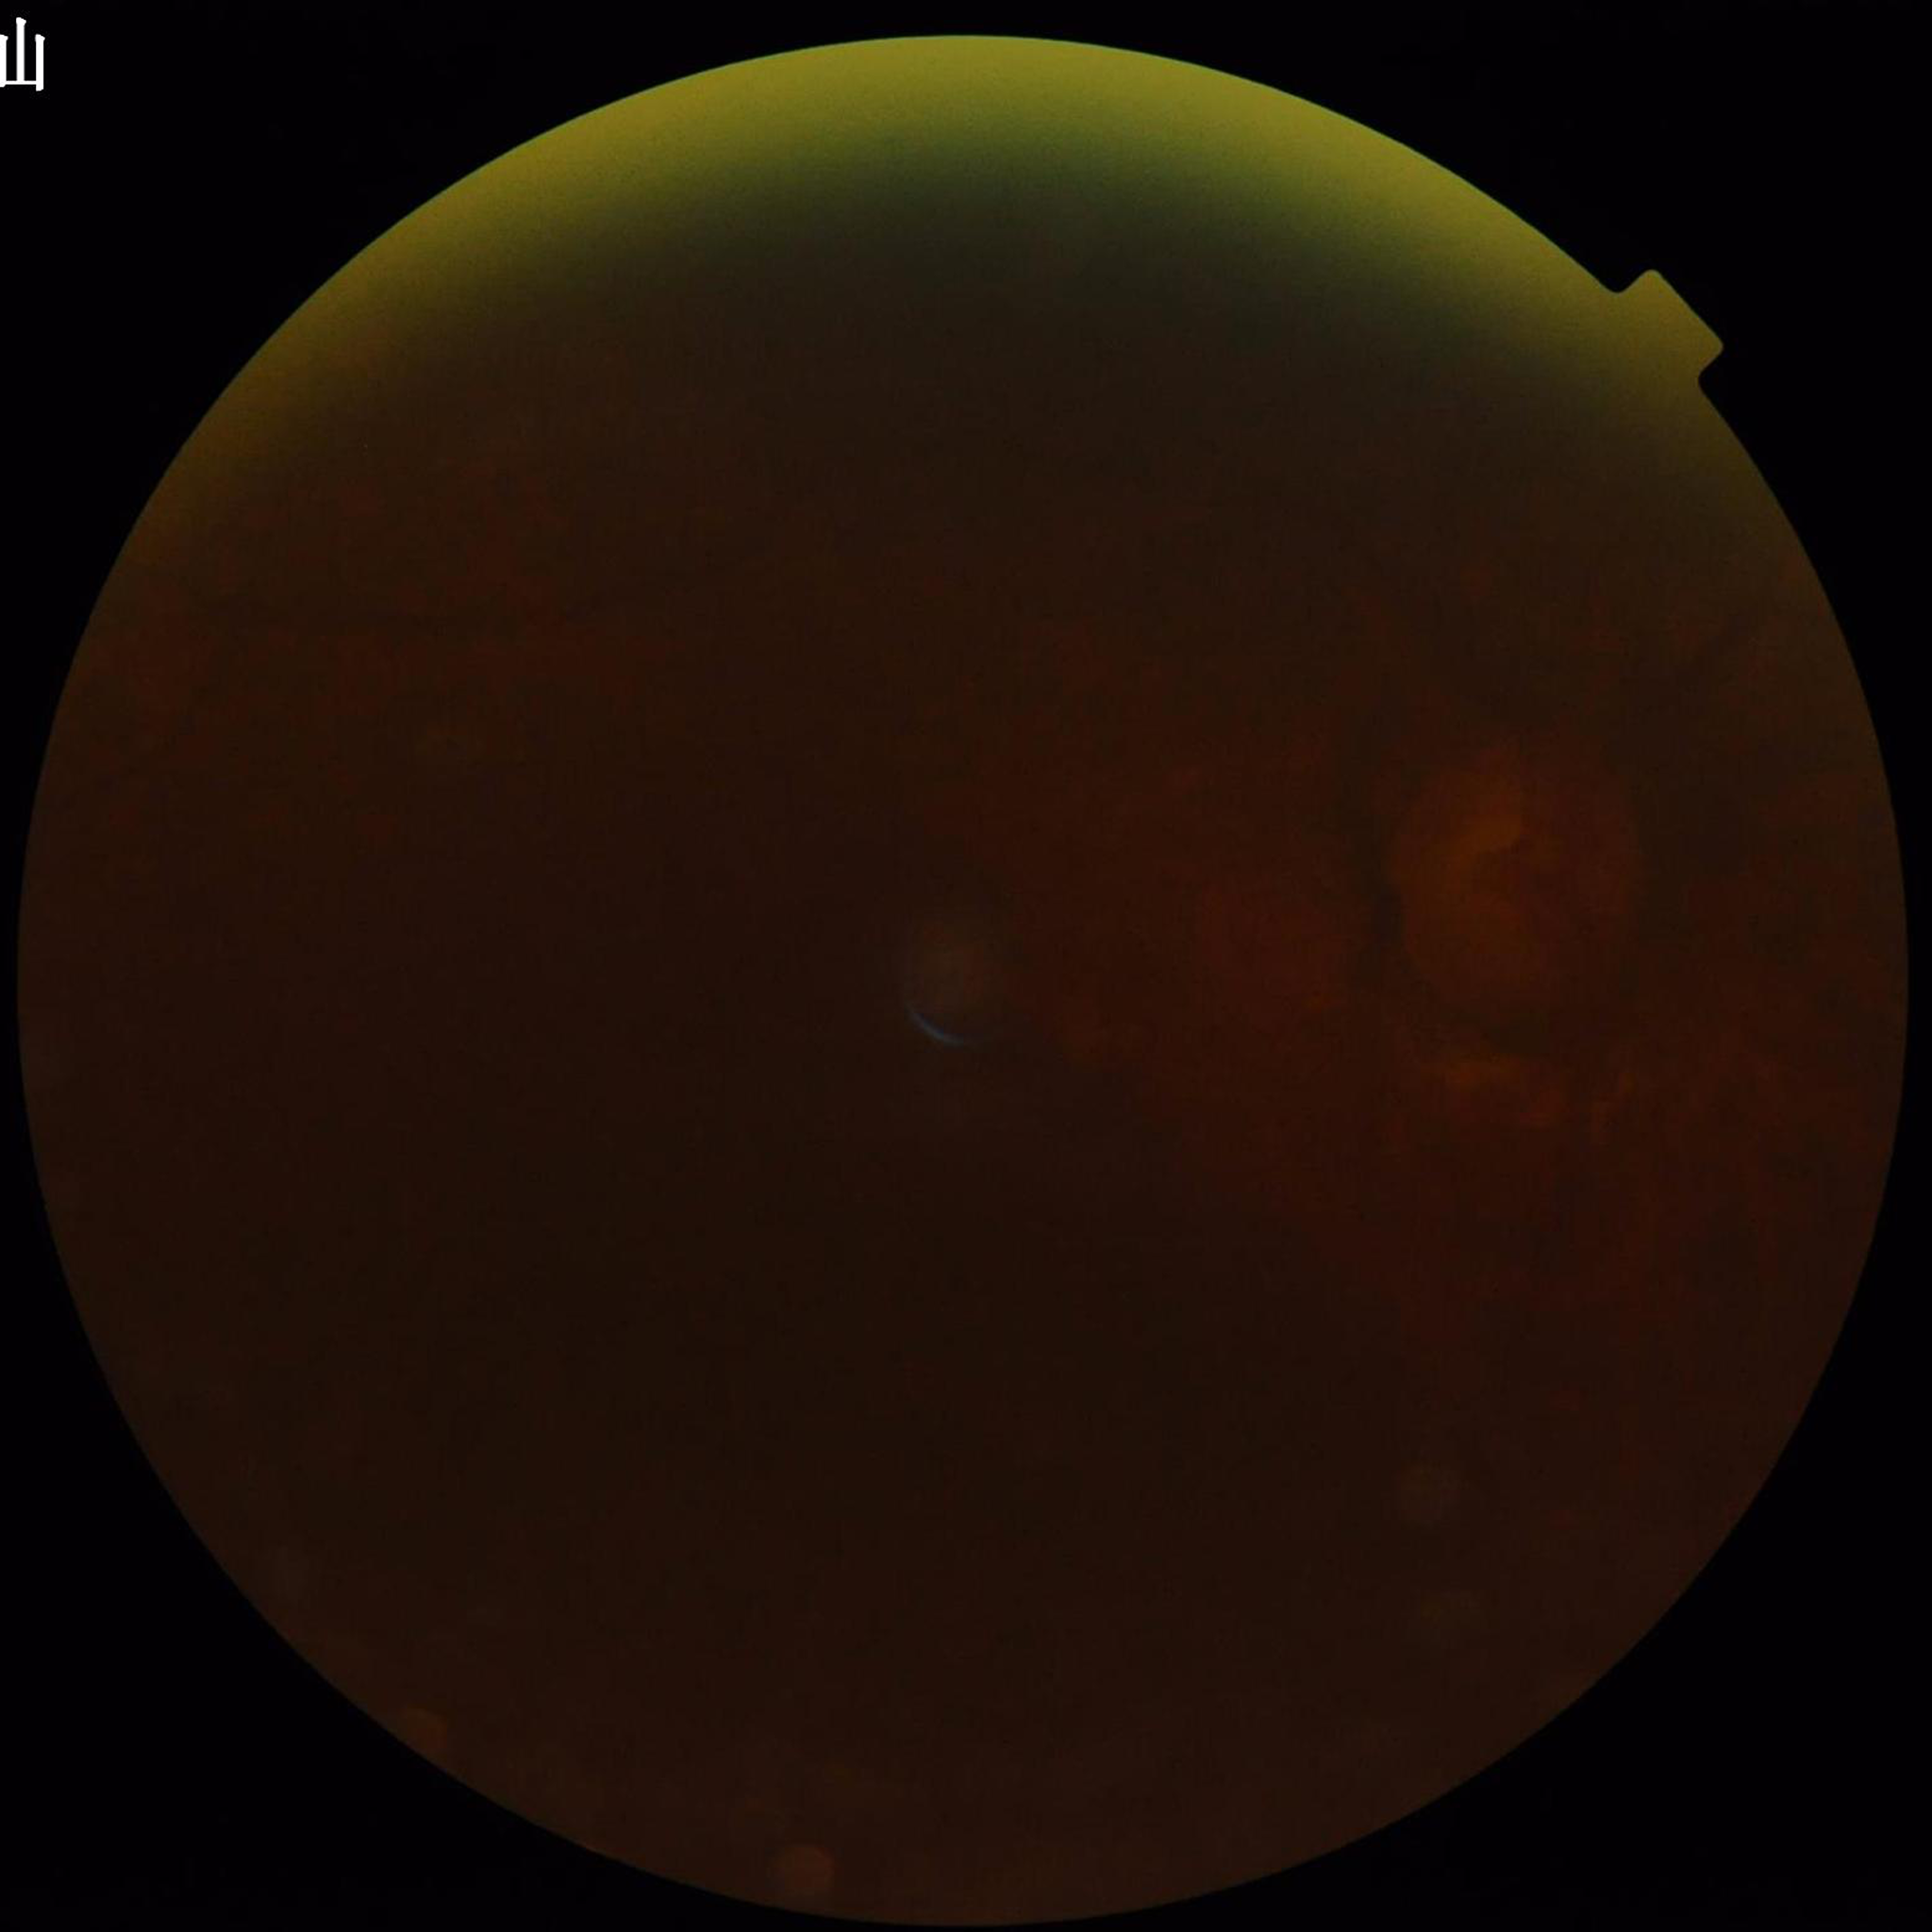
Quality: reduced — illumination/color distortion, blur, low contrast.
This fundus photograph is from a patient diagnosed with glaucoma.